CFP. FOV: 50 degrees.
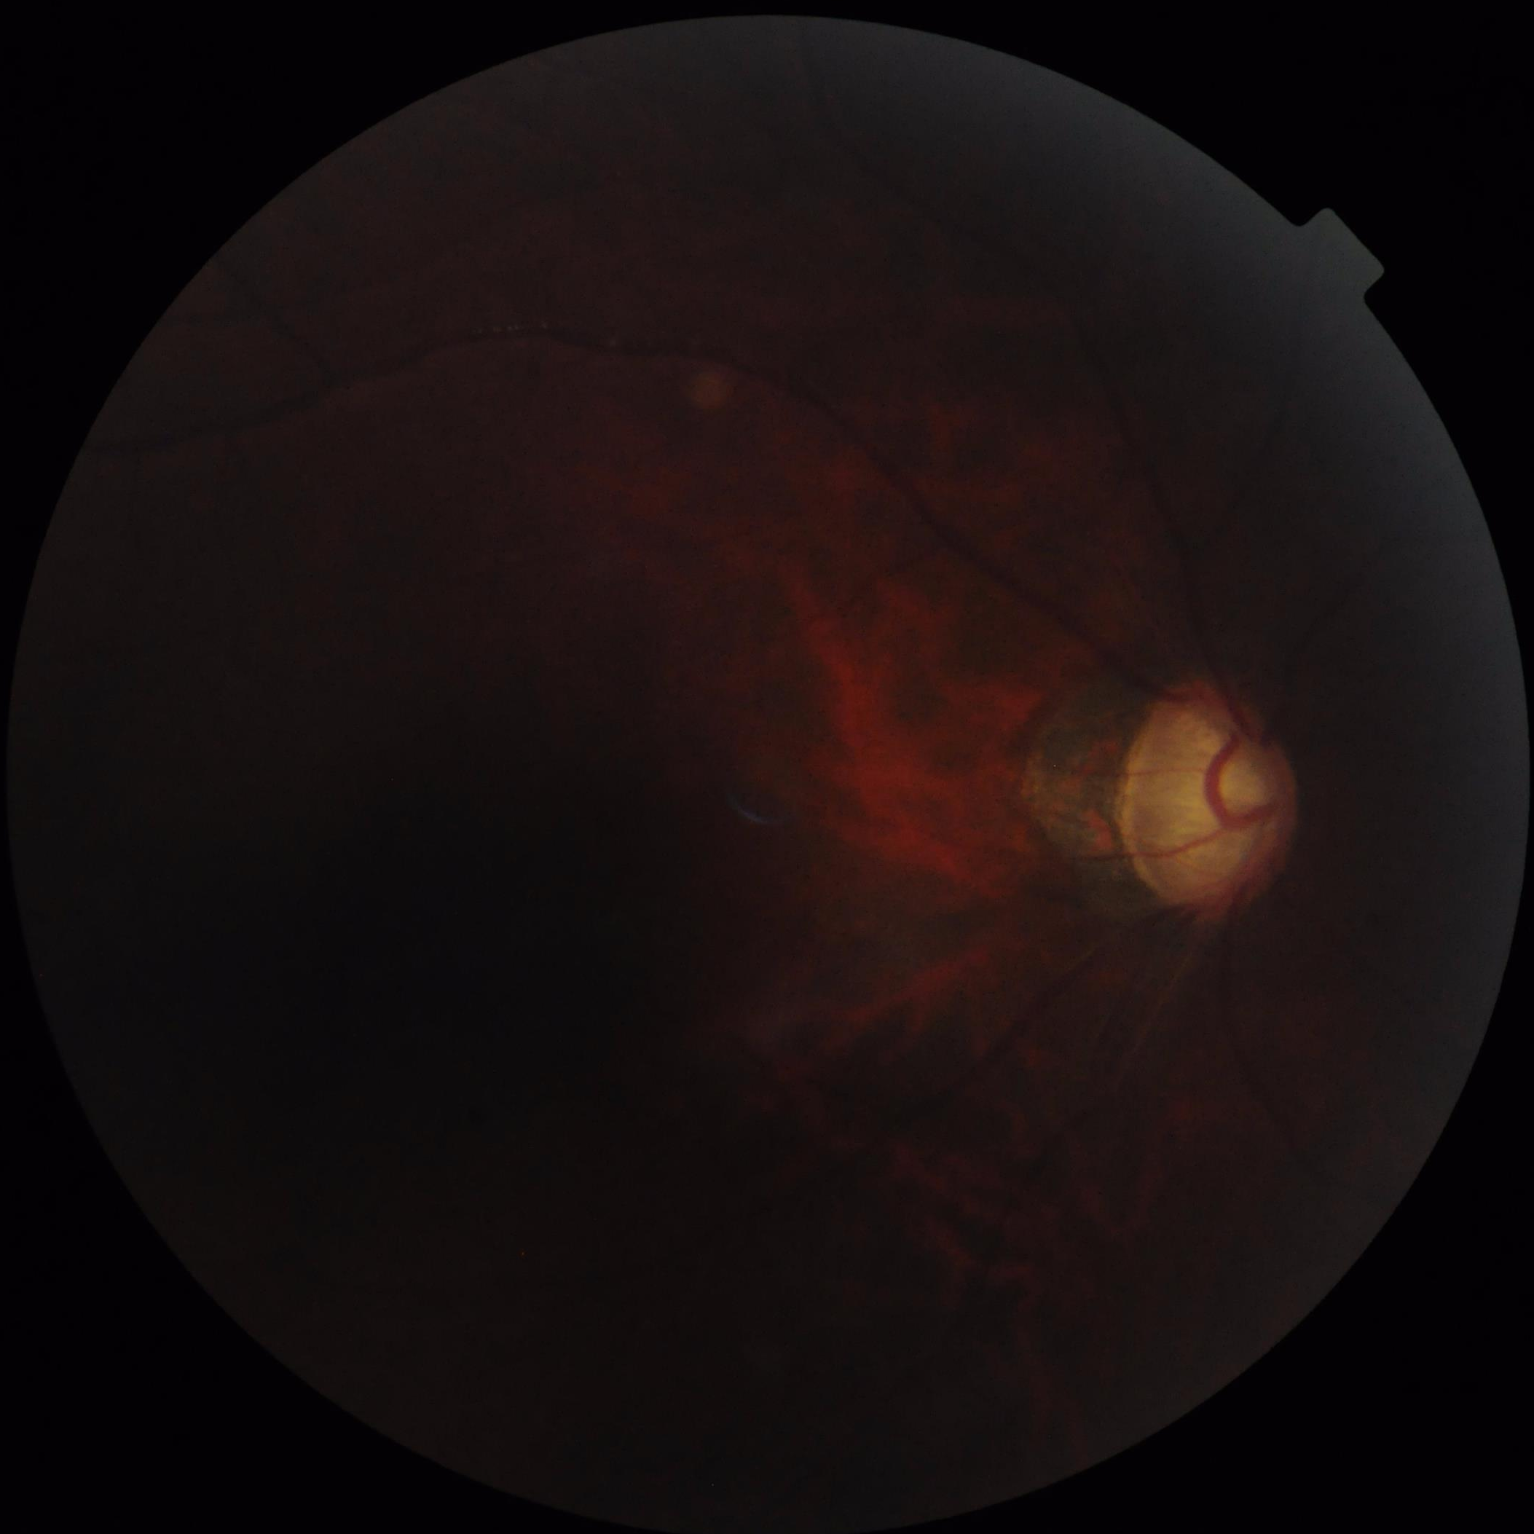
There is over- or under-exposure or a color cast. Overall quality is poor; the image is difficult to grade. The image is blurry. Poor dynamic range.